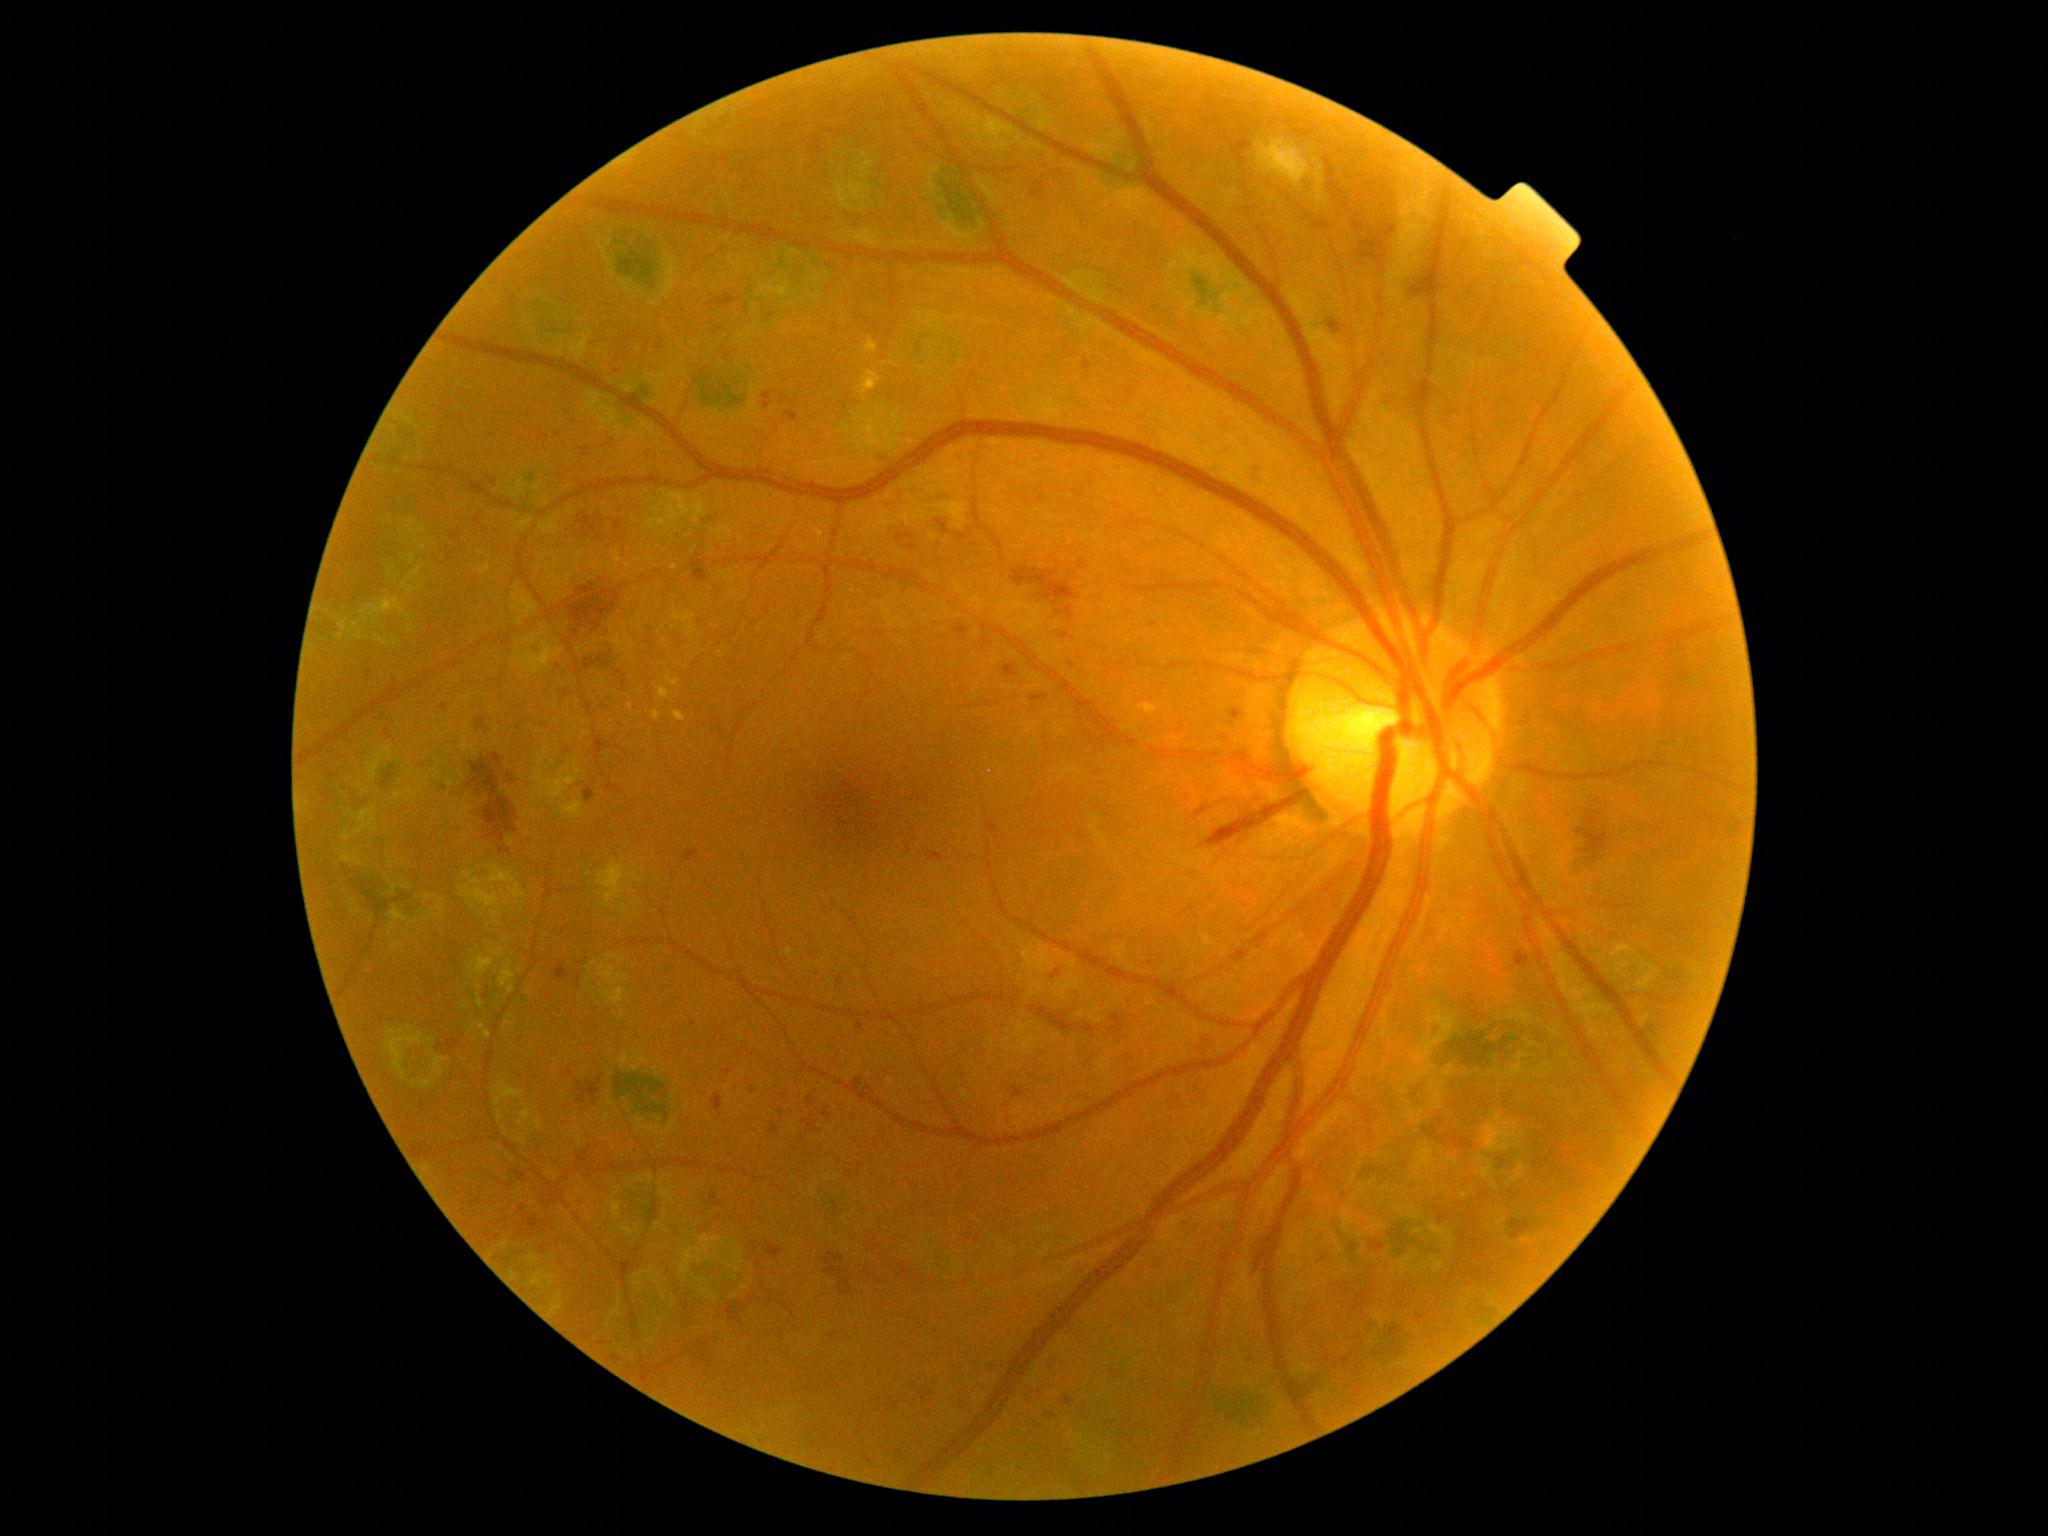
Diabetic retinopathy (DR): 3.